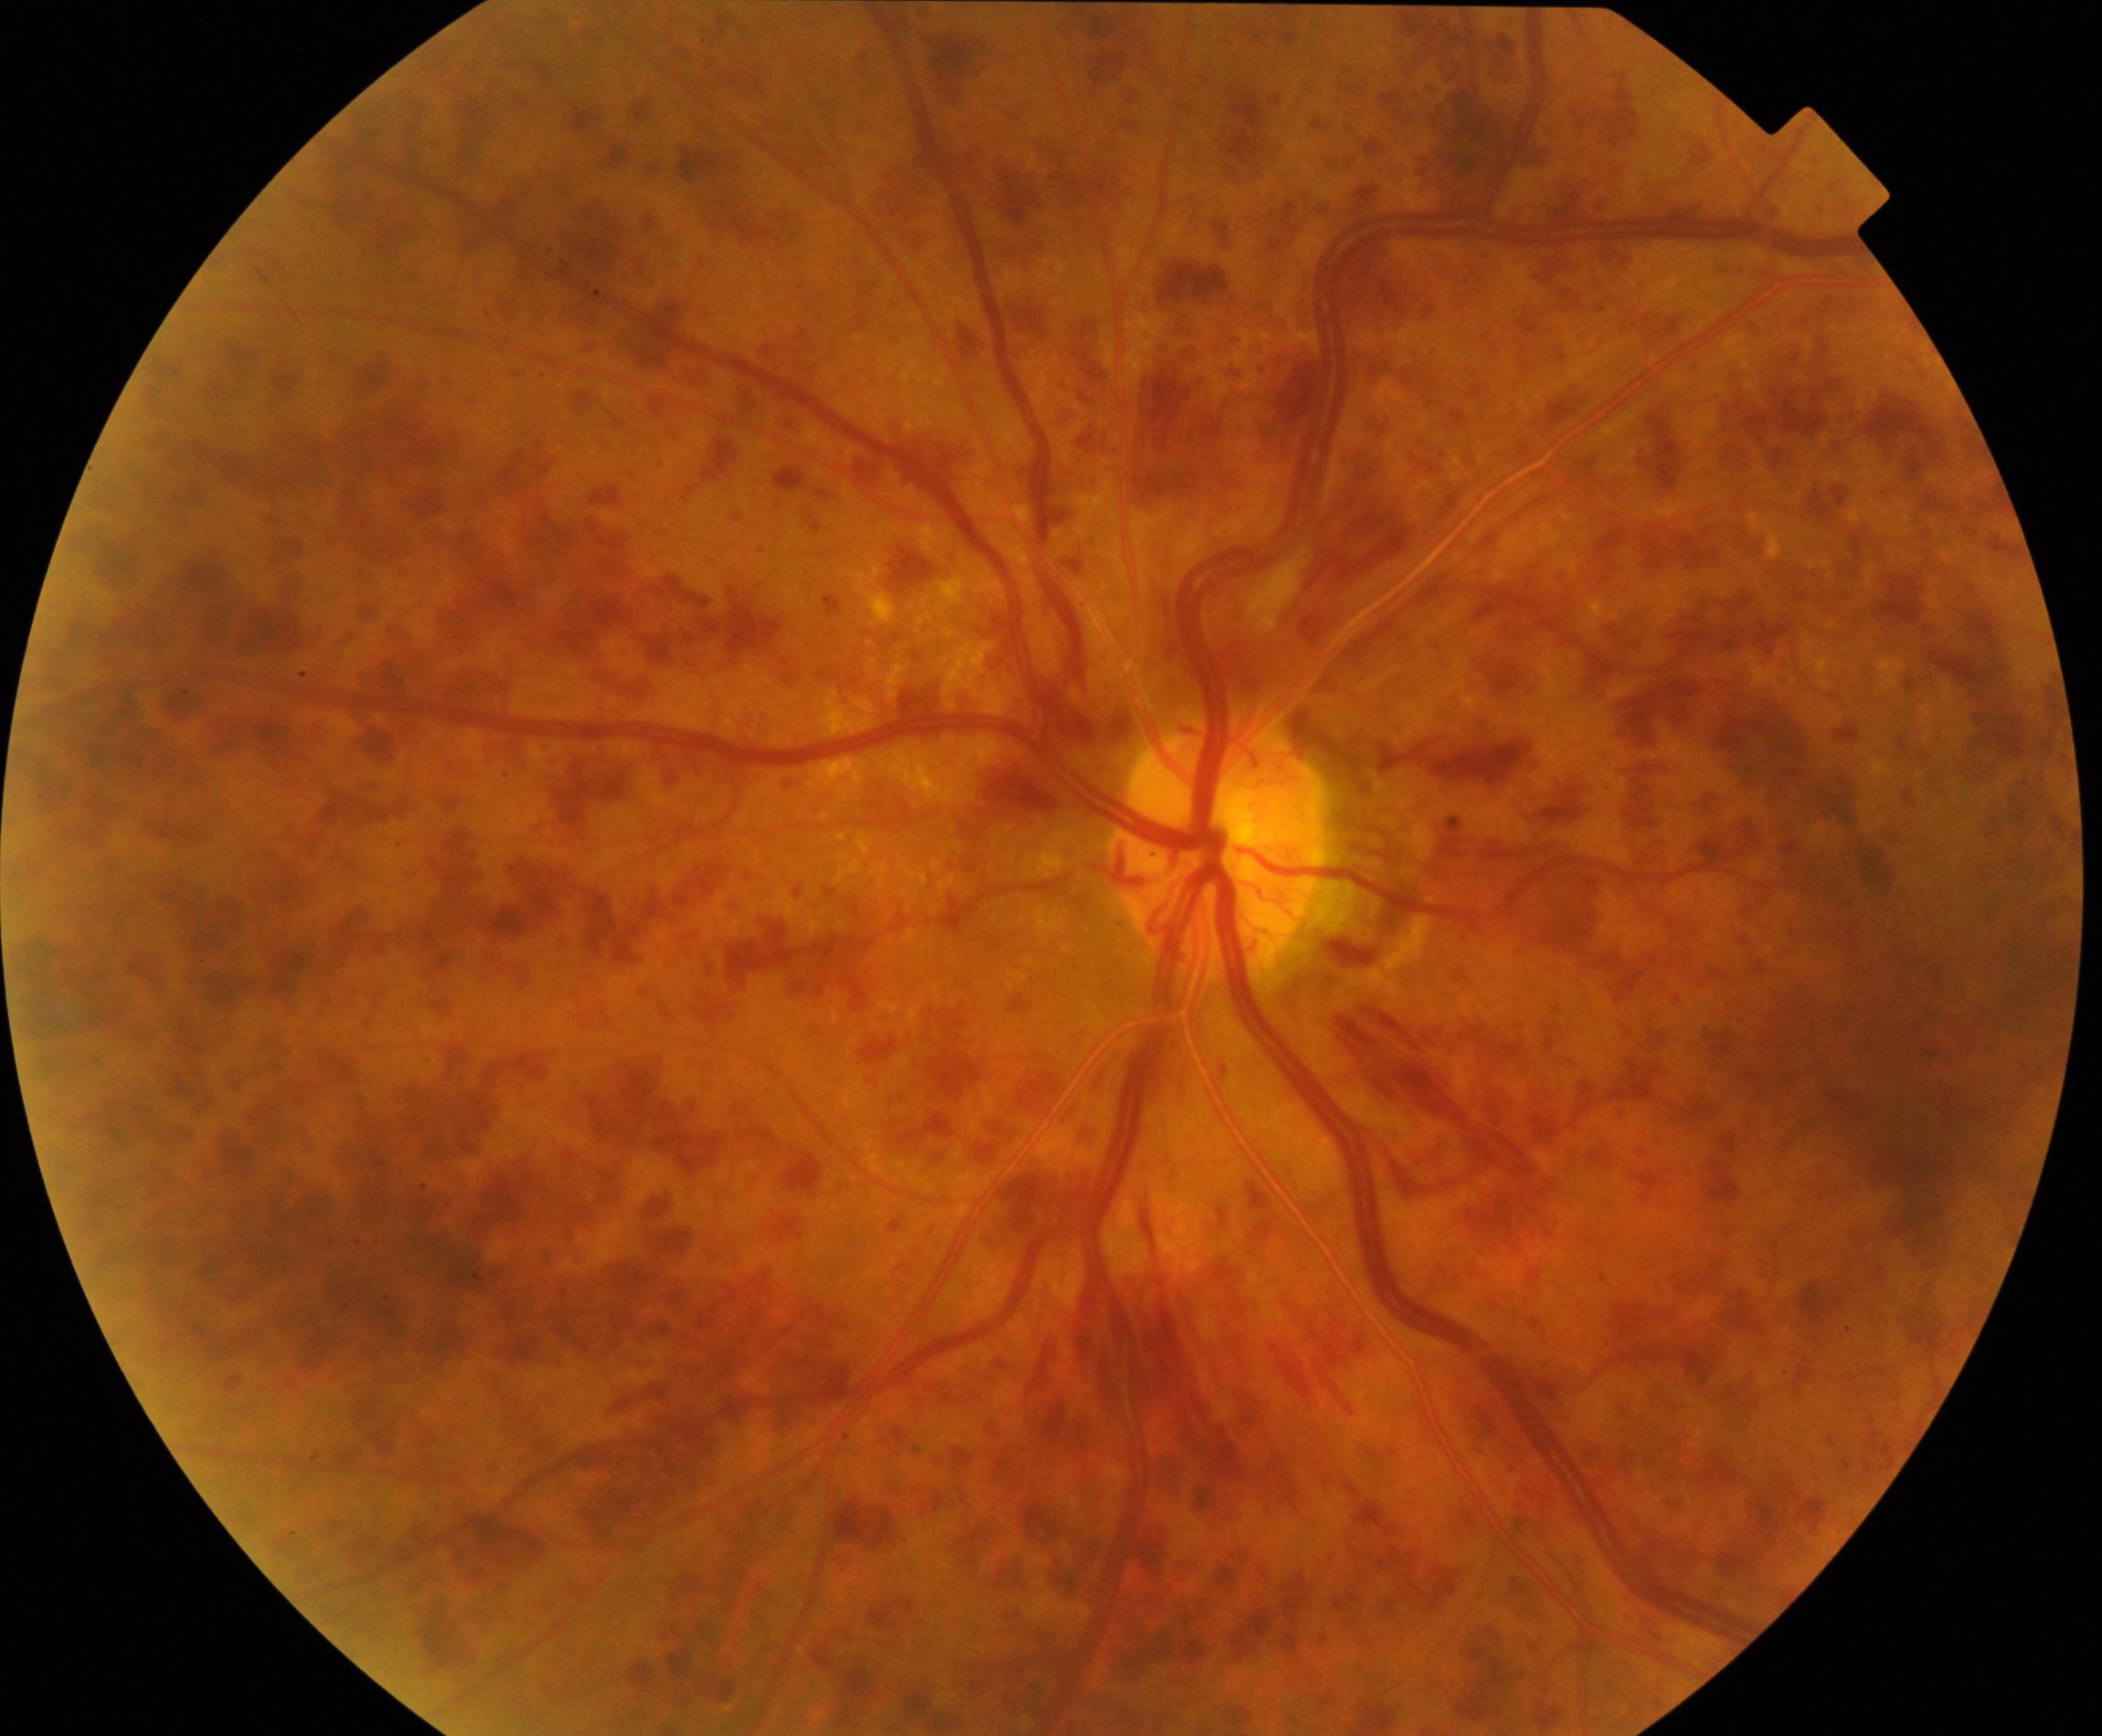
Color fundus photograph showing CRVO (central retinal vein occlusion).